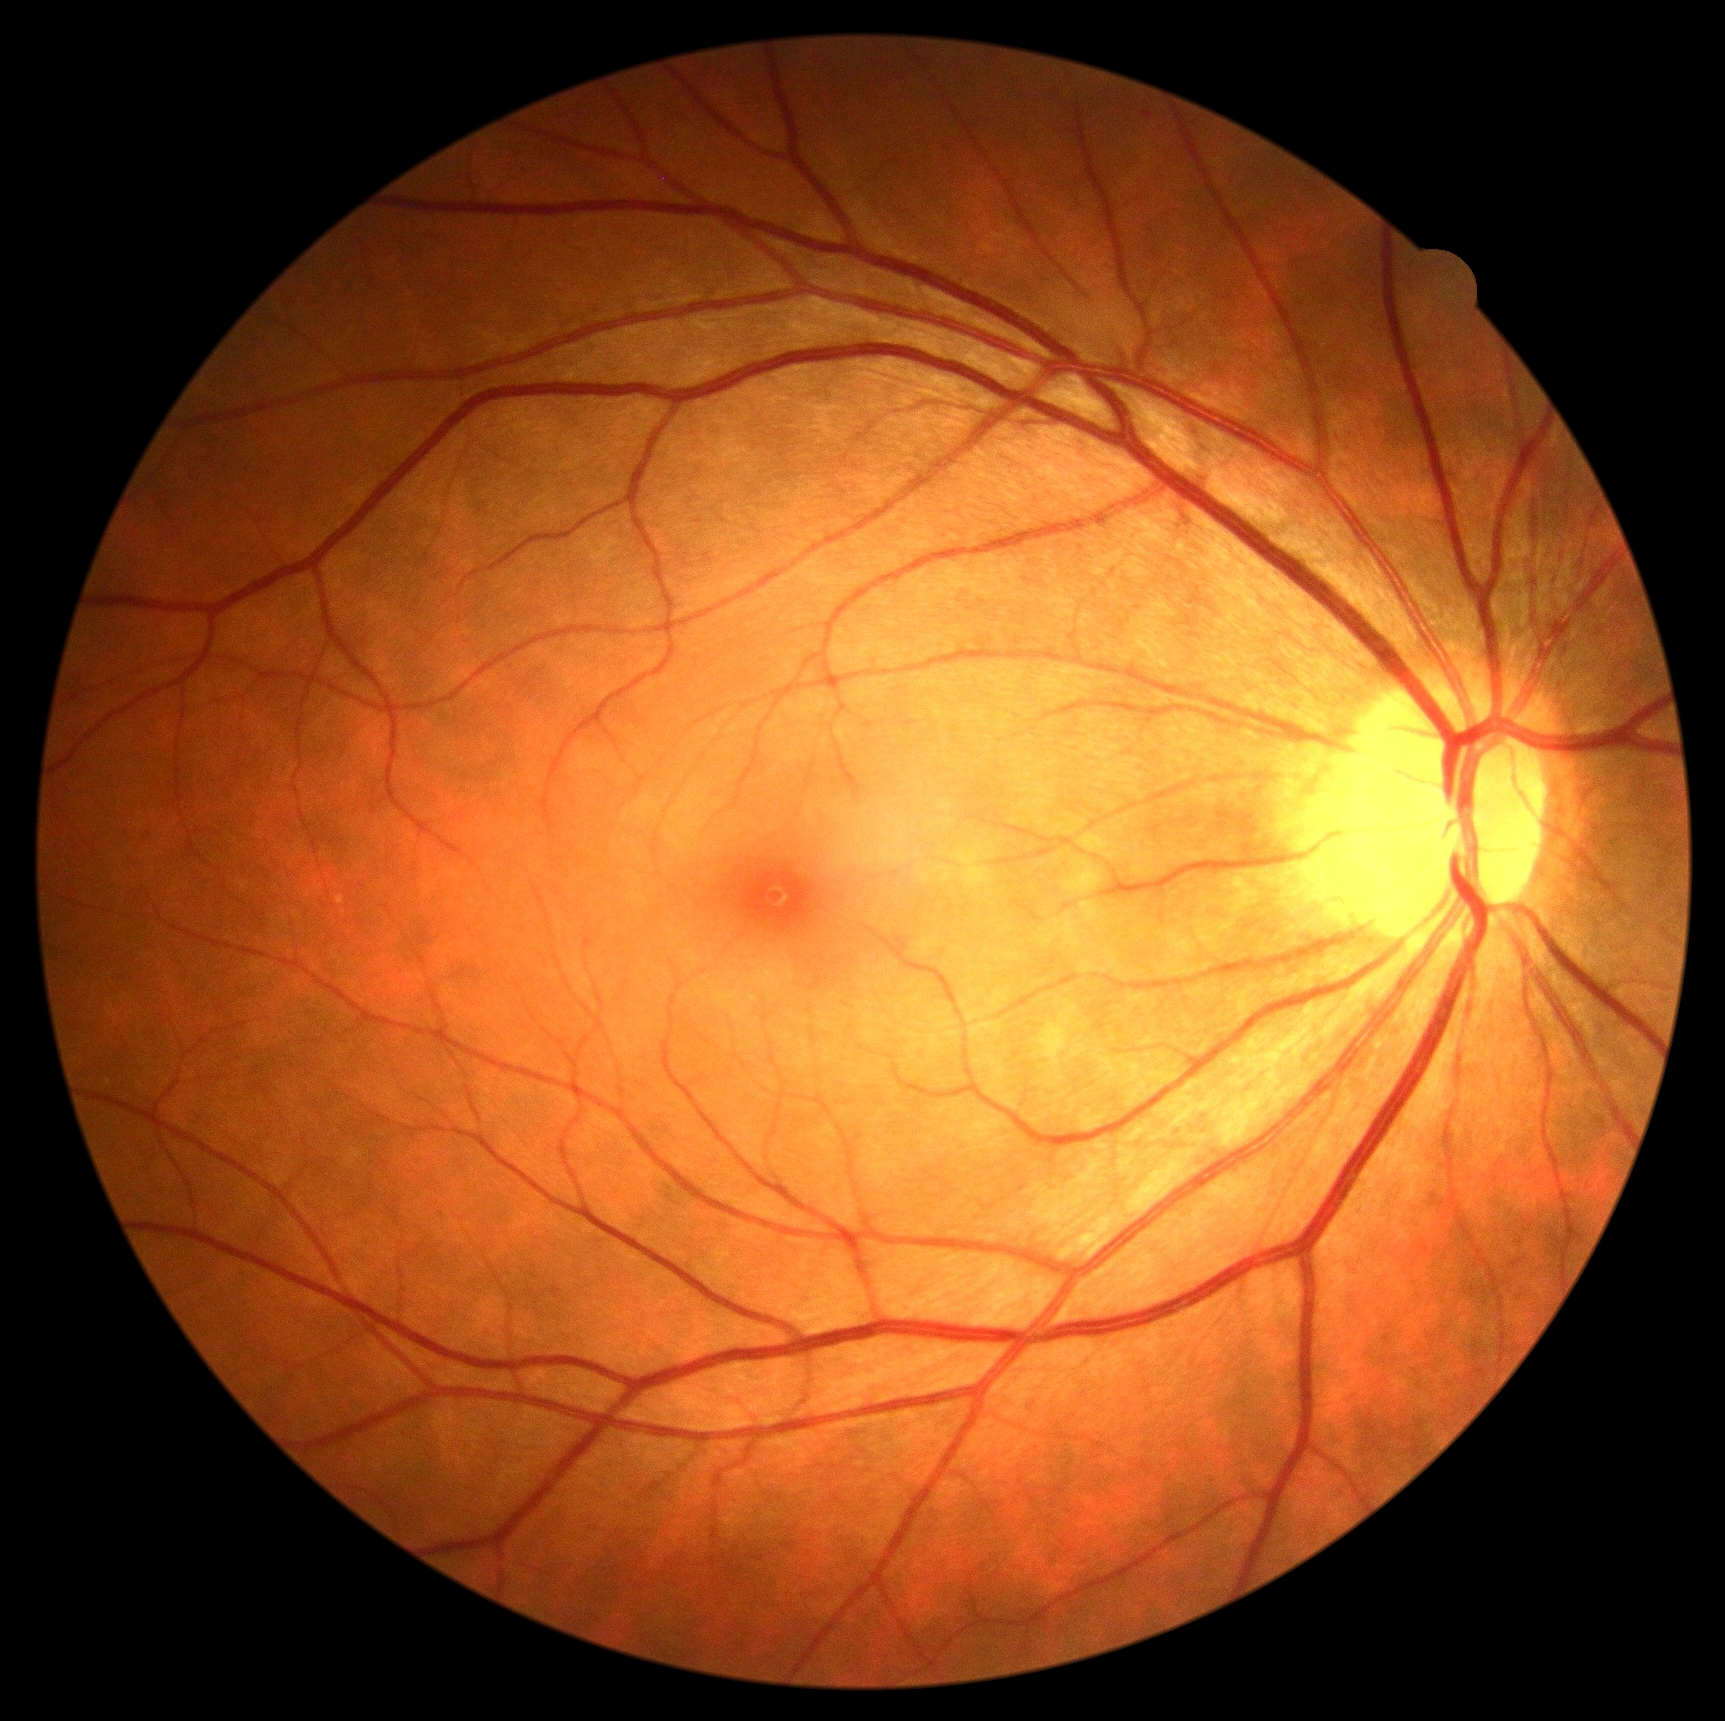
Findings:
• DR — grade 0